Image size 848x848. Modified Davis classification
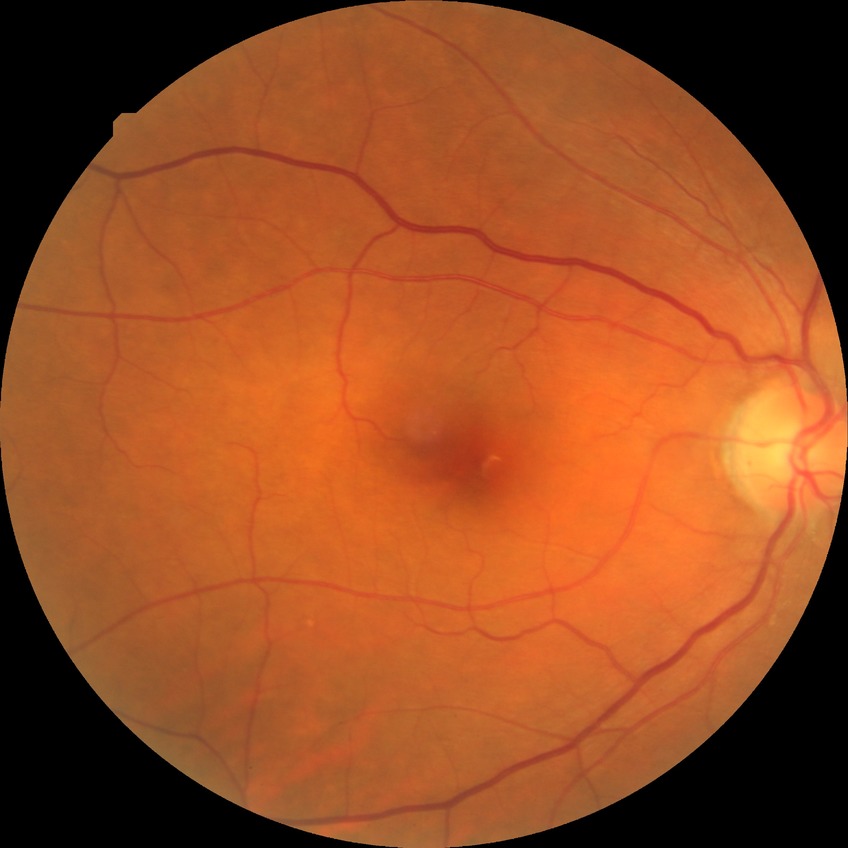
{"davis_grade": "SDR"}